Color fundus image. Image size 2048x1536. 45° FOV.
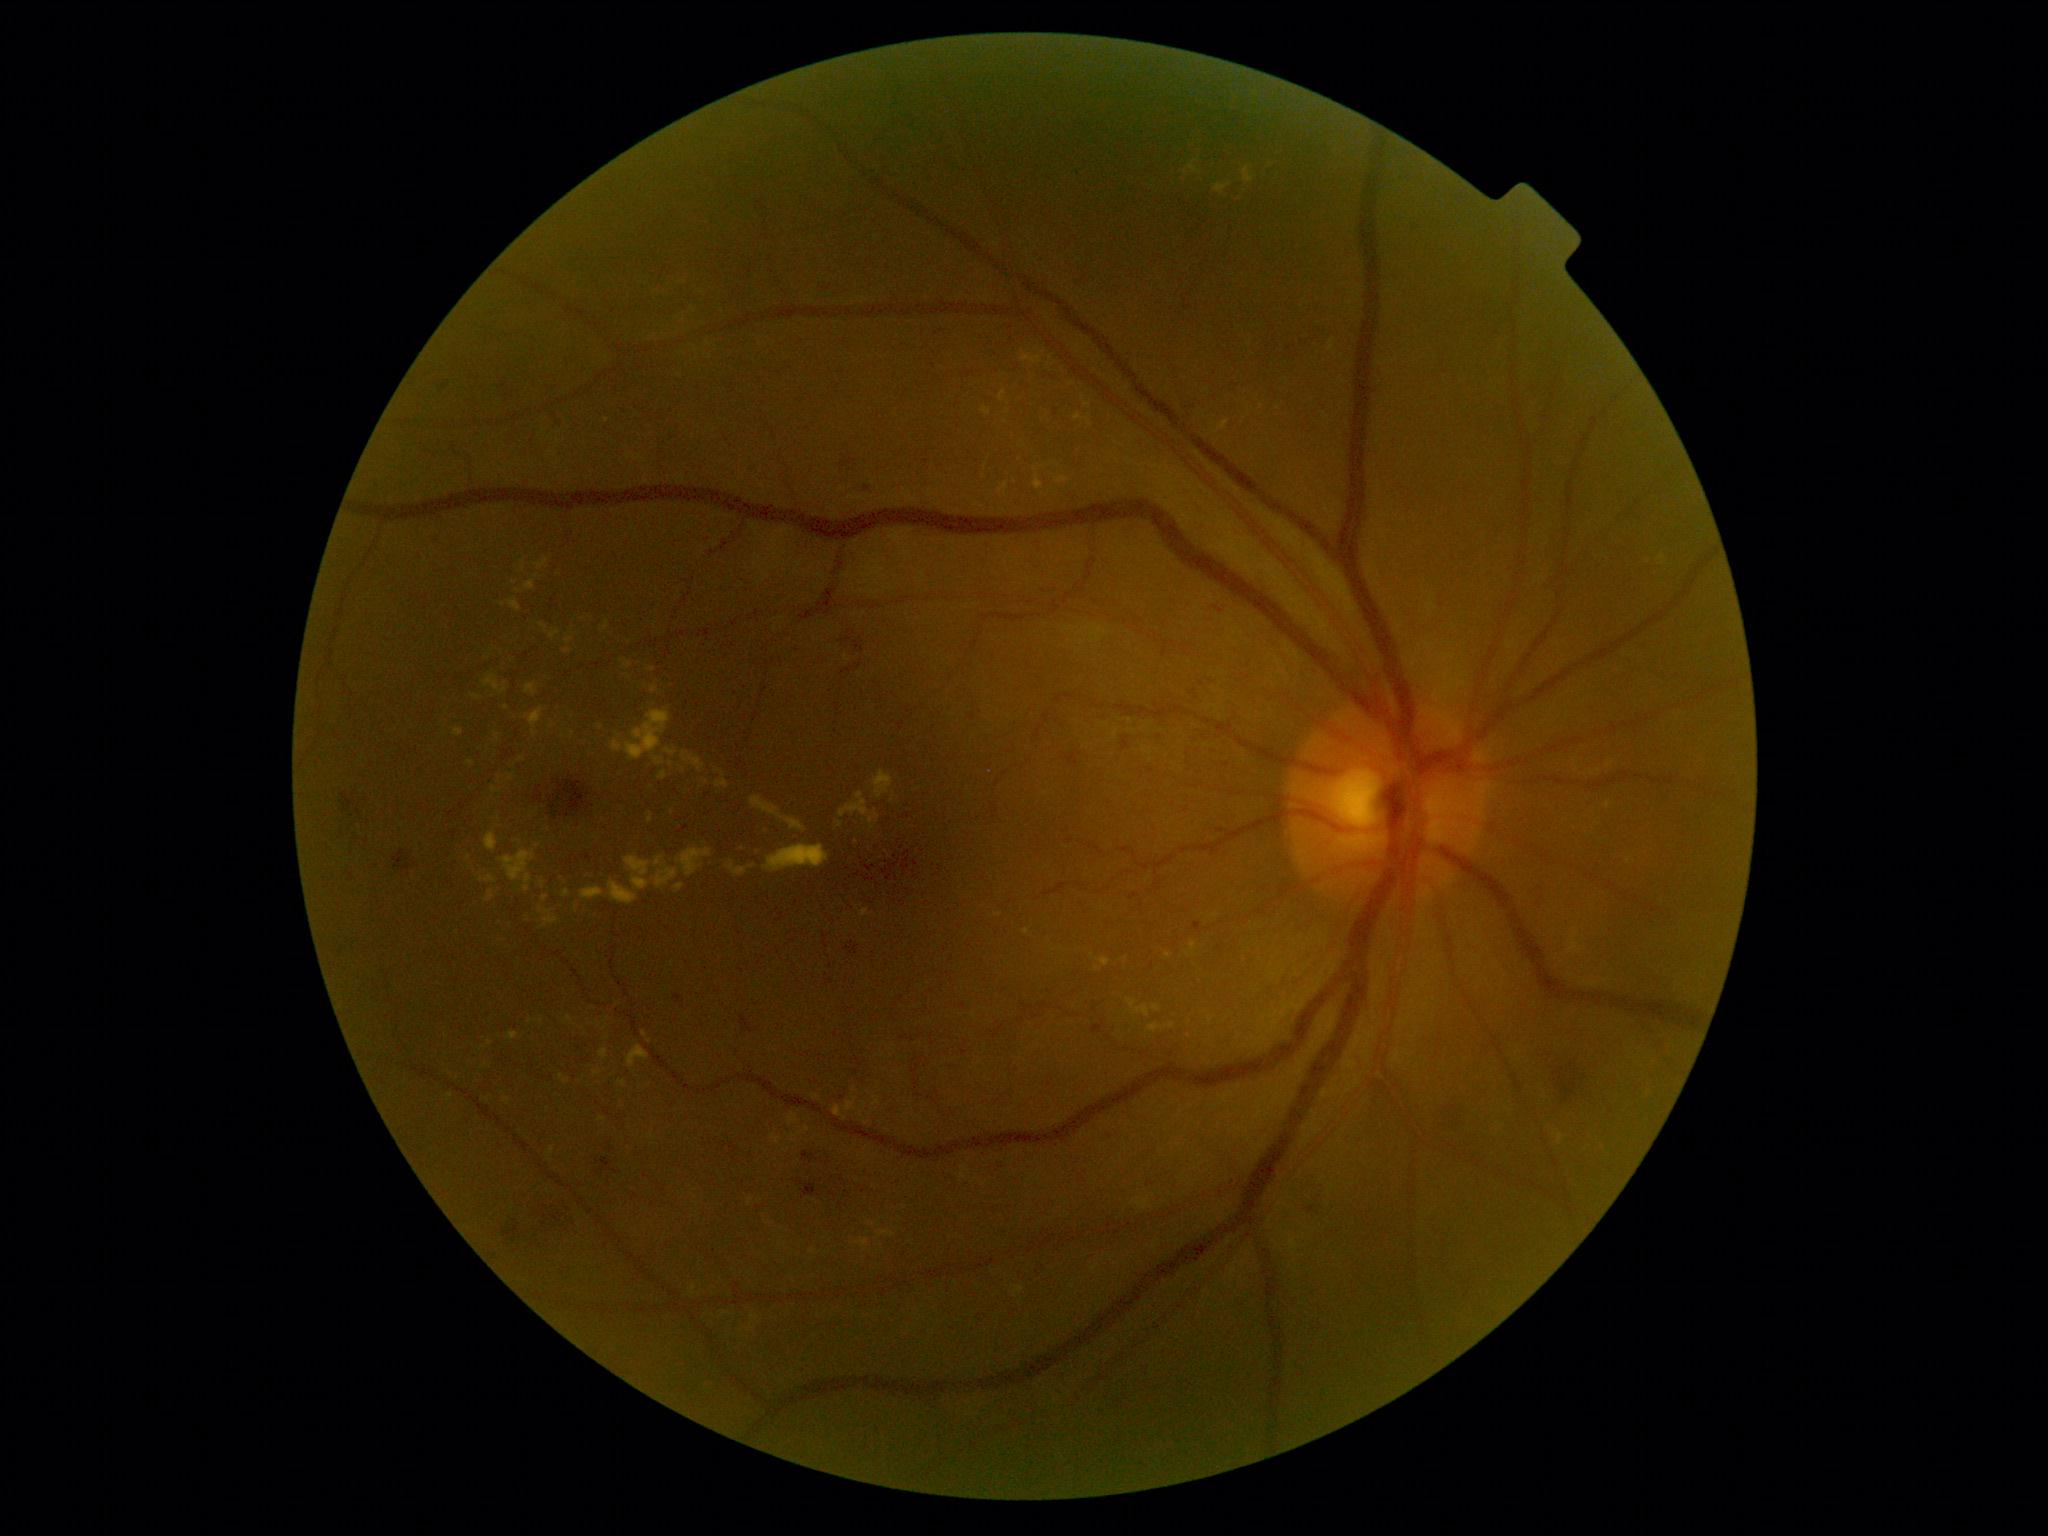
partial: true
dr_grade: 2
dr_grade_name: moderate NPDR
lesions:
  ex:
    - region(565, 637, 574, 644)
    - region(845, 1097, 856, 1111)
    - region(677, 849, 713, 876)
    - region(1022, 355, 1044, 365)
    - region(528, 707, 544, 737)
    - region(789, 1114, 799, 1125)
    - region(549, 630, 561, 640)
    - region(771, 1134, 780, 1144)
    - region(494, 732, 501, 742)
  ex_small_approx:
    - [x=813, y=1251]
    - [x=619, y=737]
    - [x=651, y=670]
    - [x=507, y=1101]
    - [x=518, y=592]
    - [x=450, y=1097]
    - [x=582, y=830]
    - [x=605, y=1028]